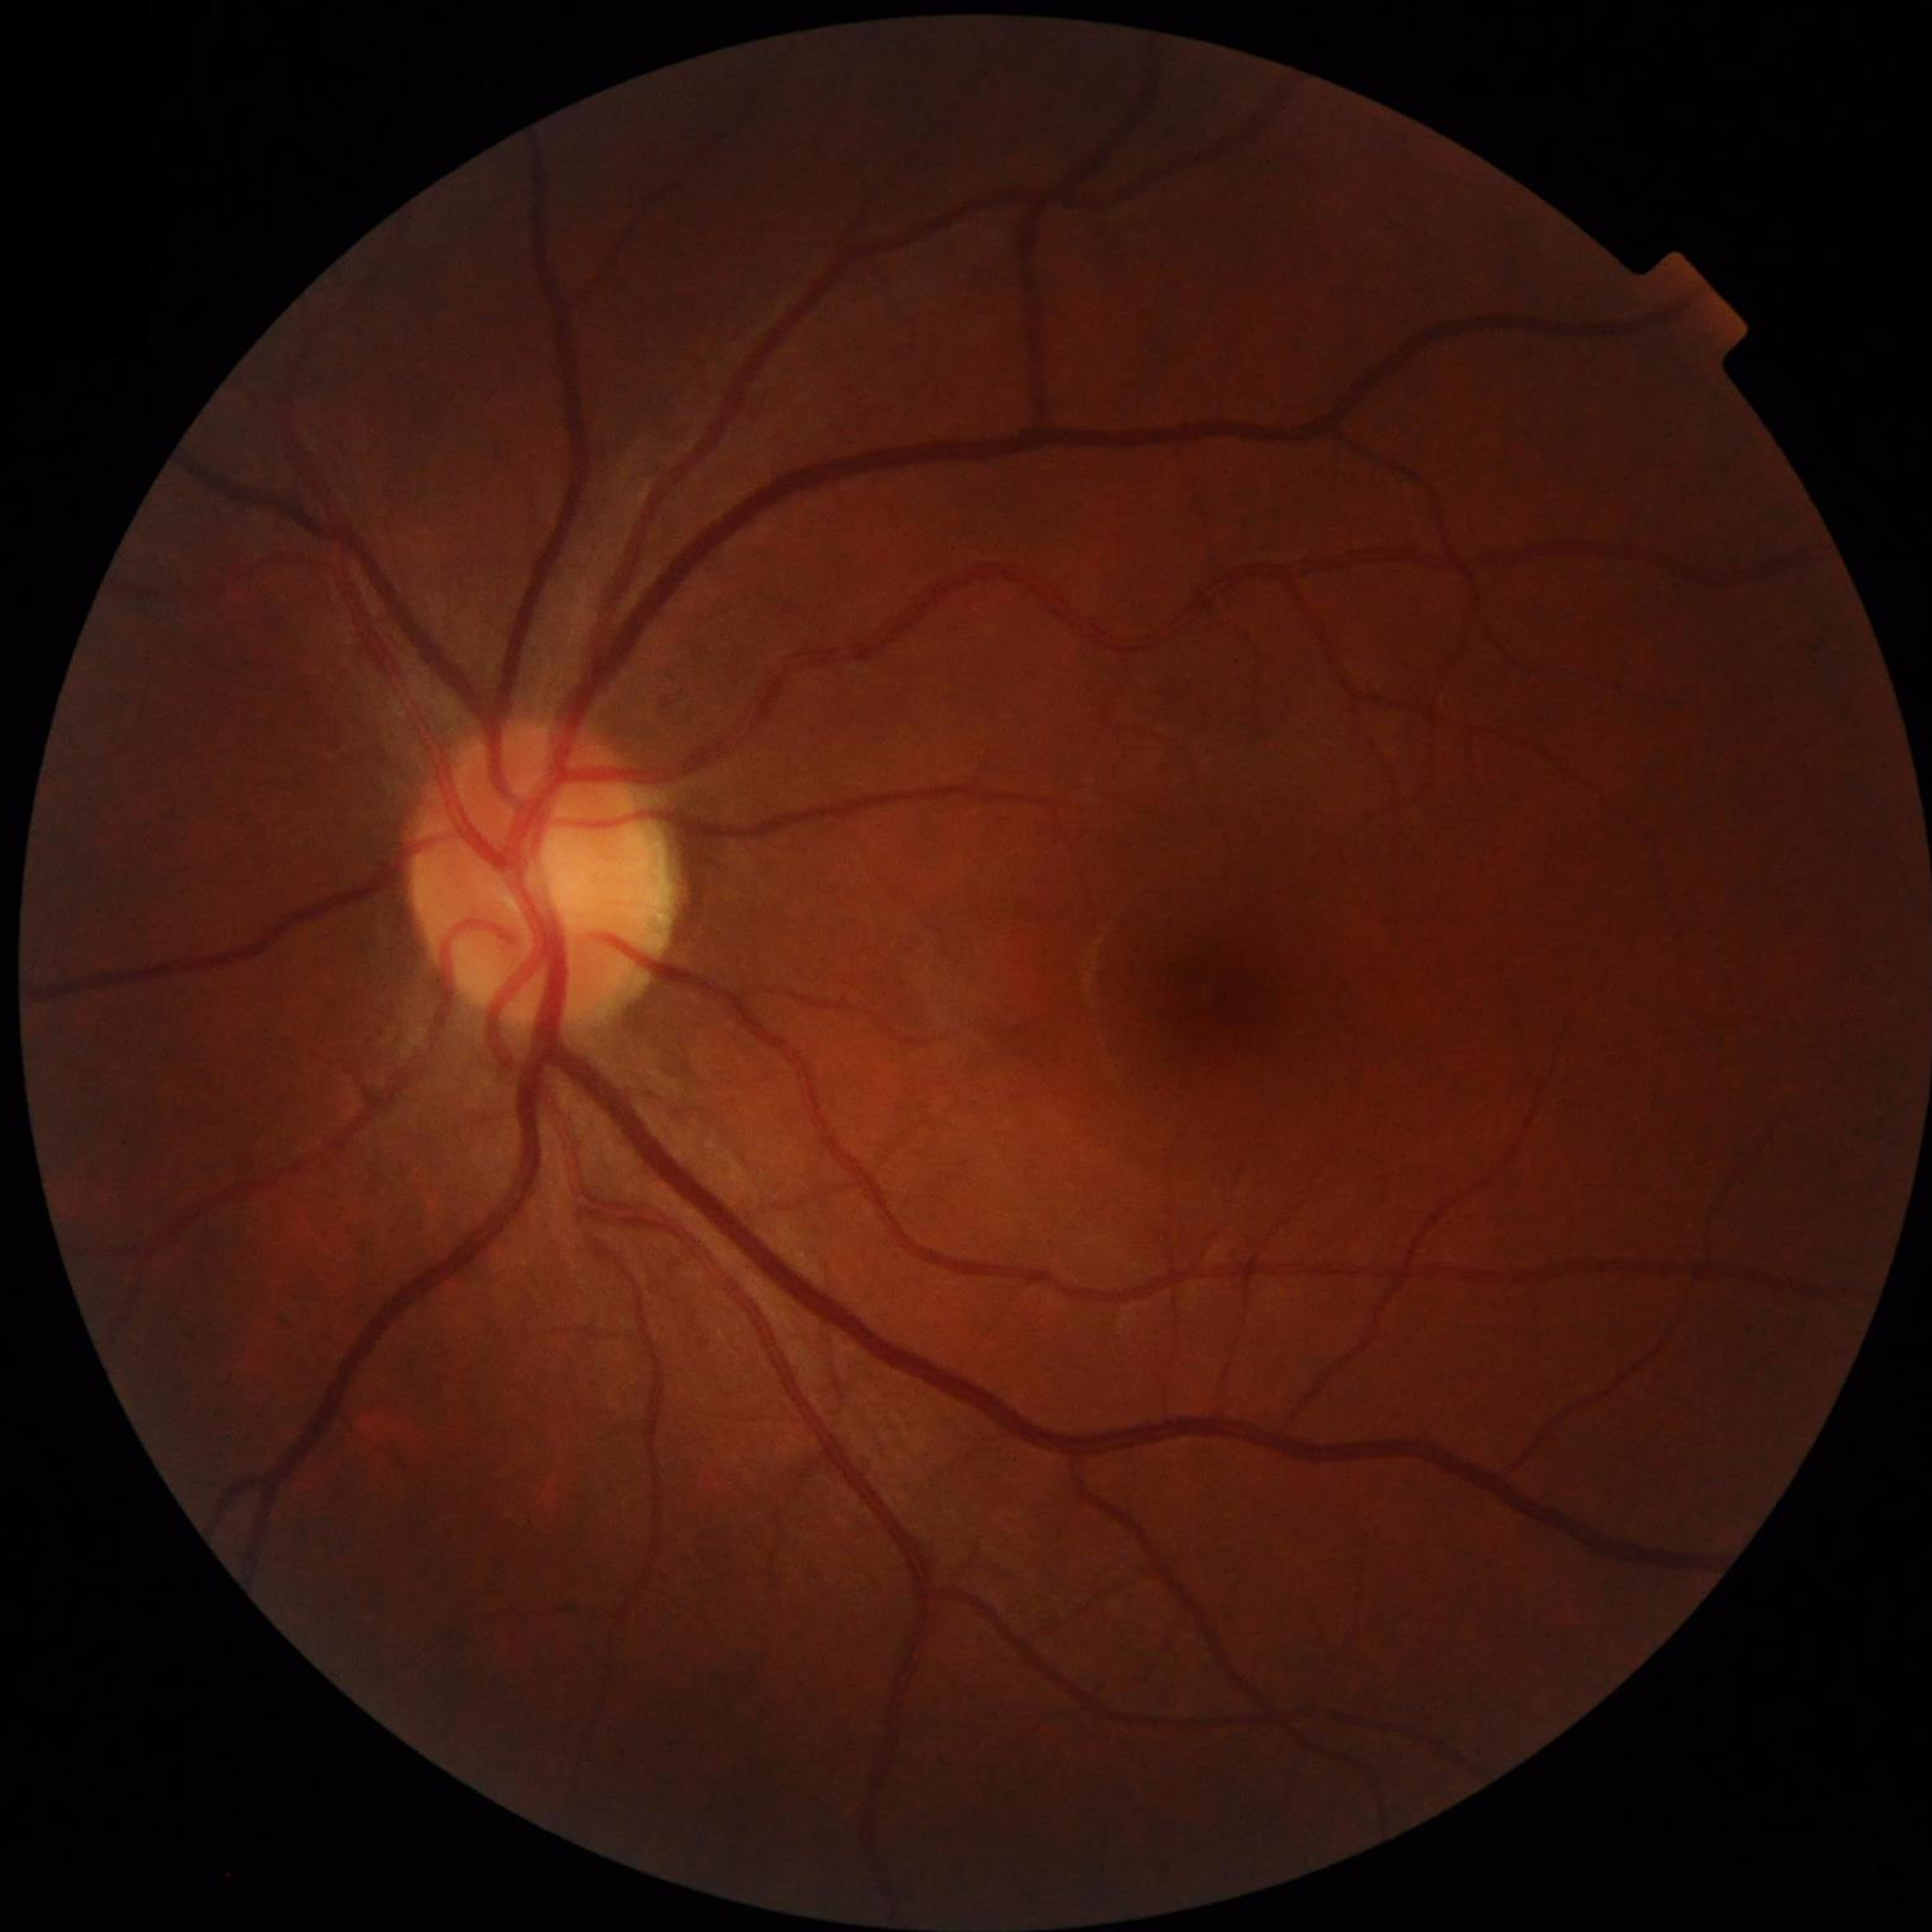
Condition = no AMD, DR, or glaucomatous findings